FOV: 45 degrees
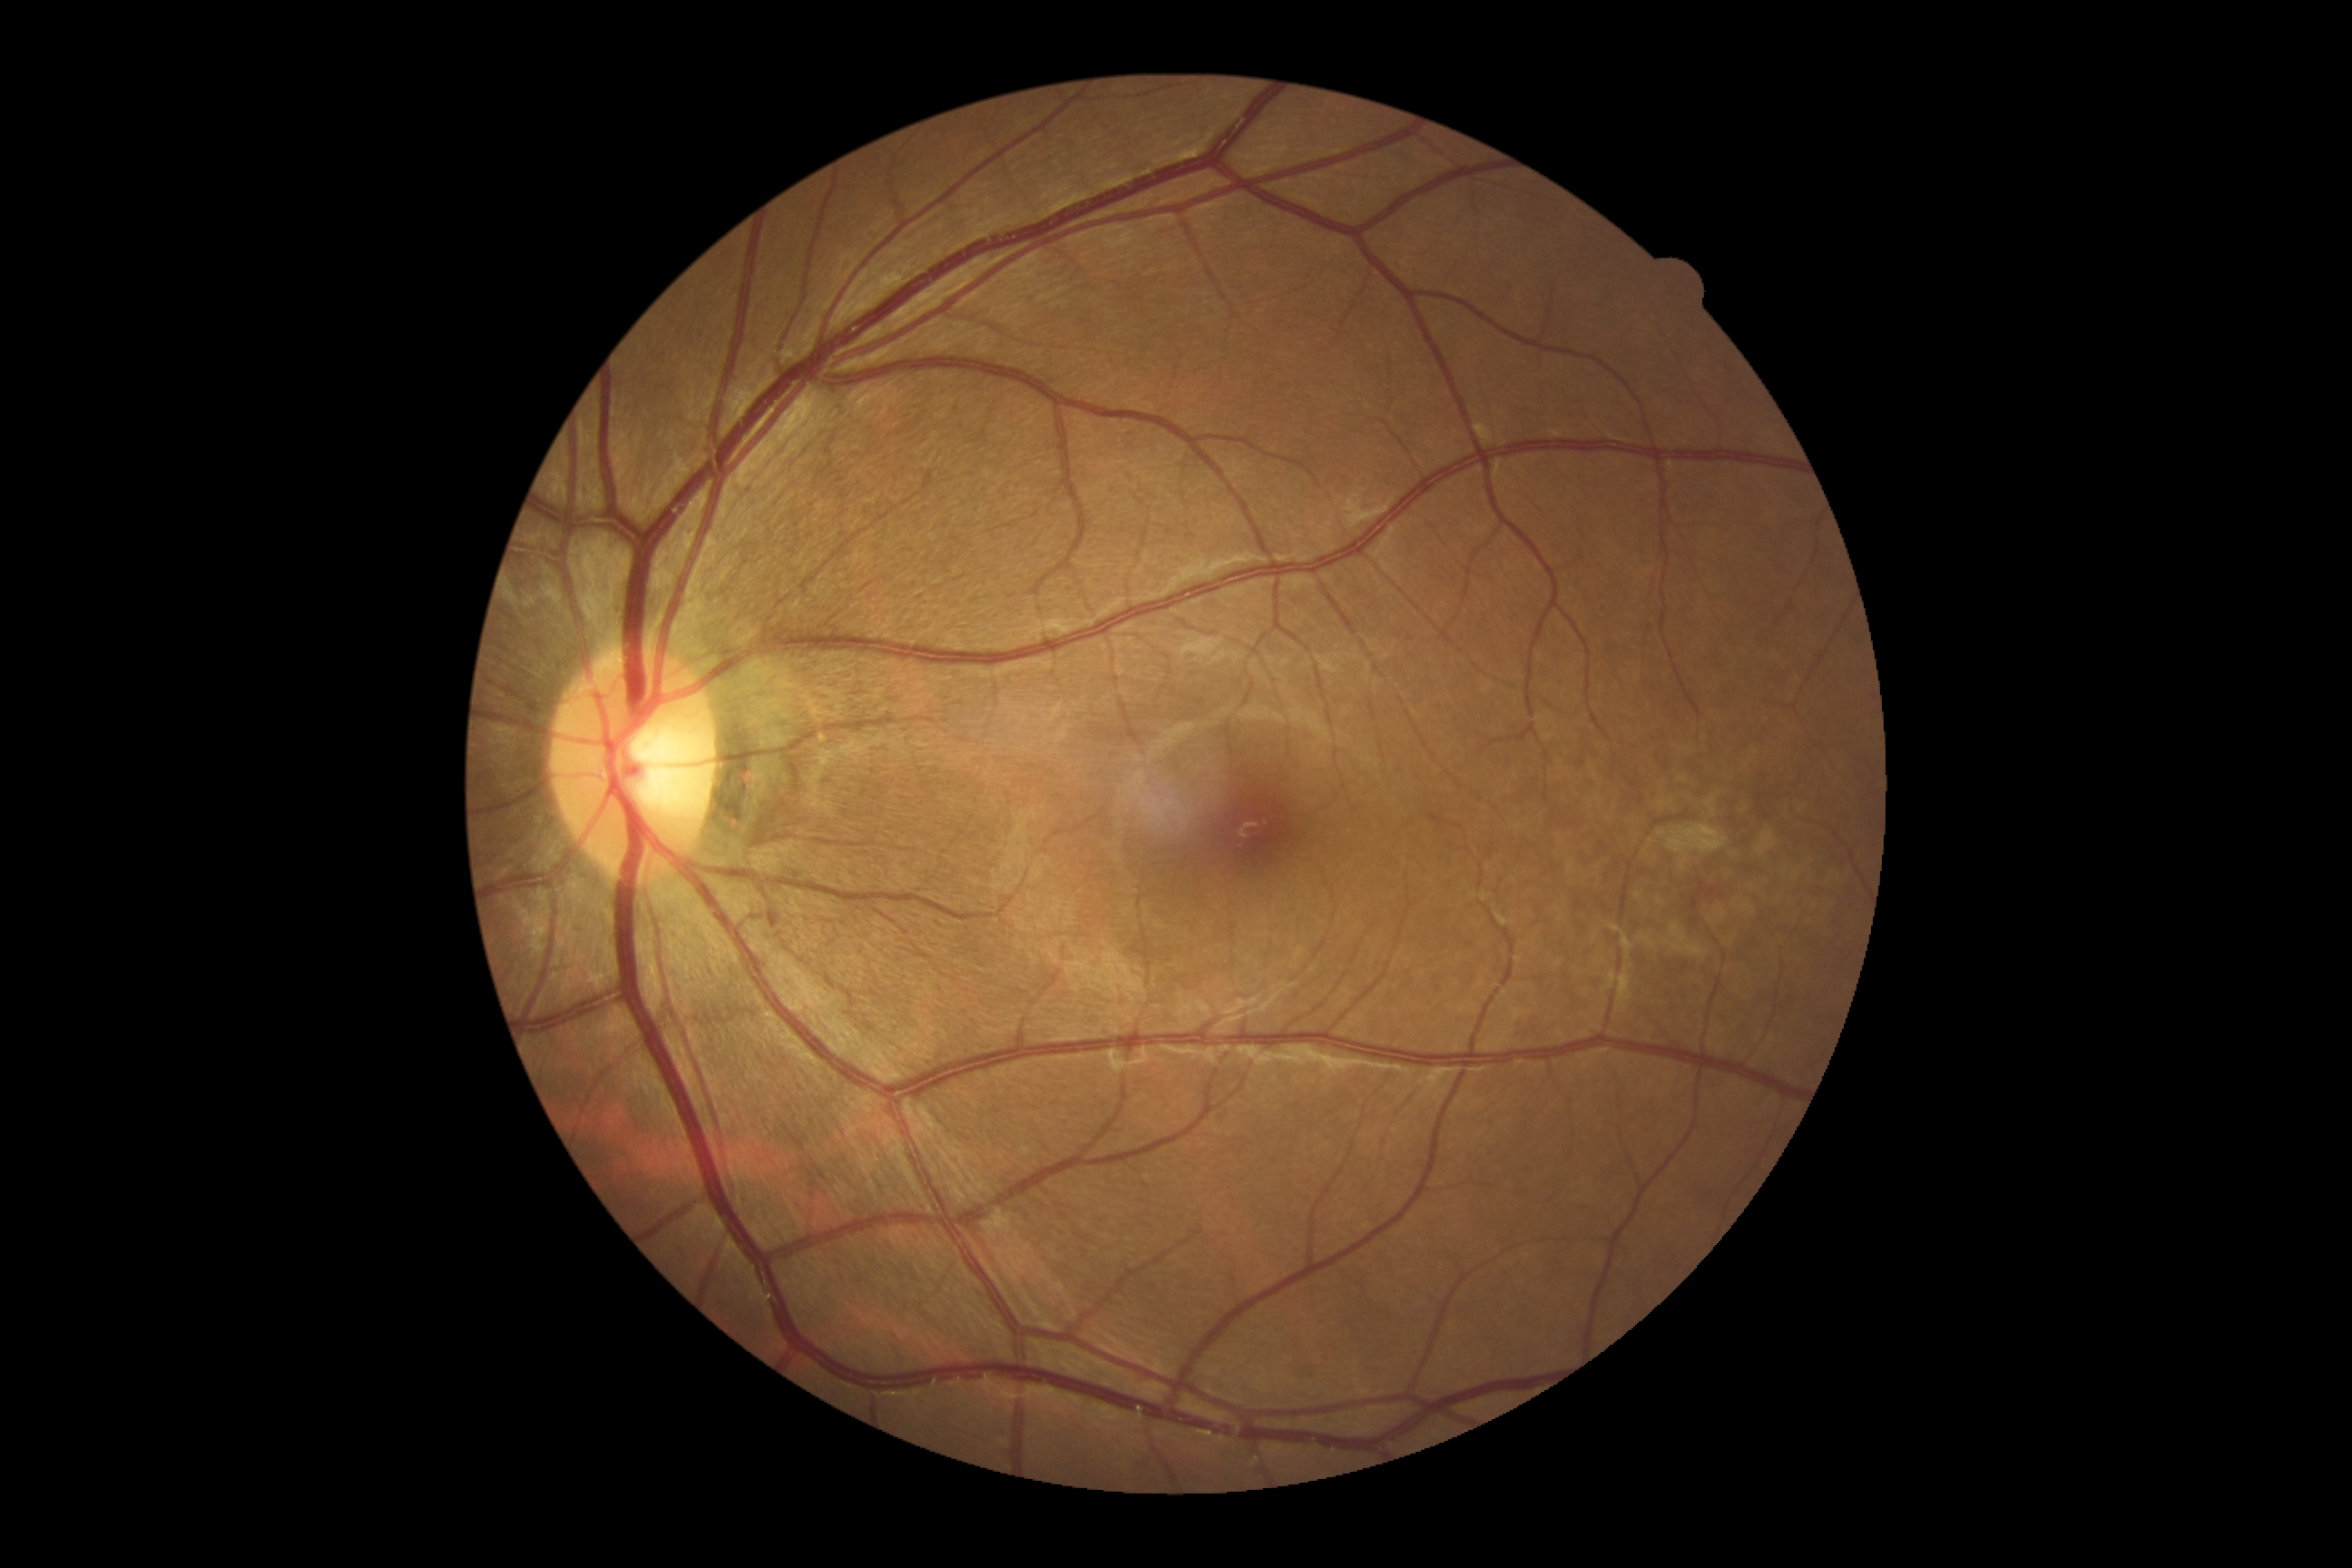 DR severity is 0/4.